Infant wide-field fundus photograph. Image size 640x480 — 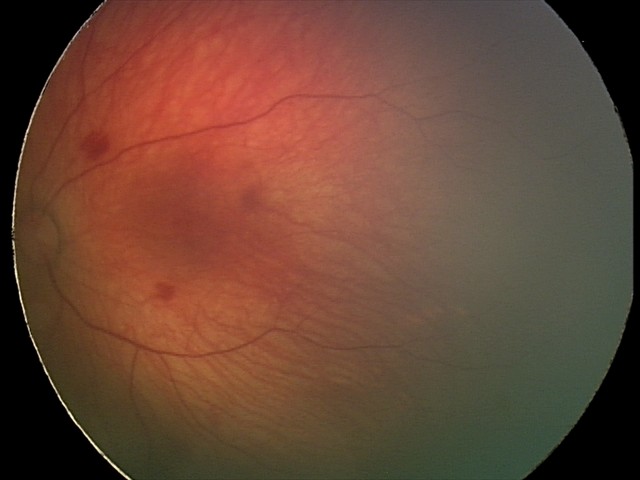 Screening examination consistent with retinal hemorrhages.